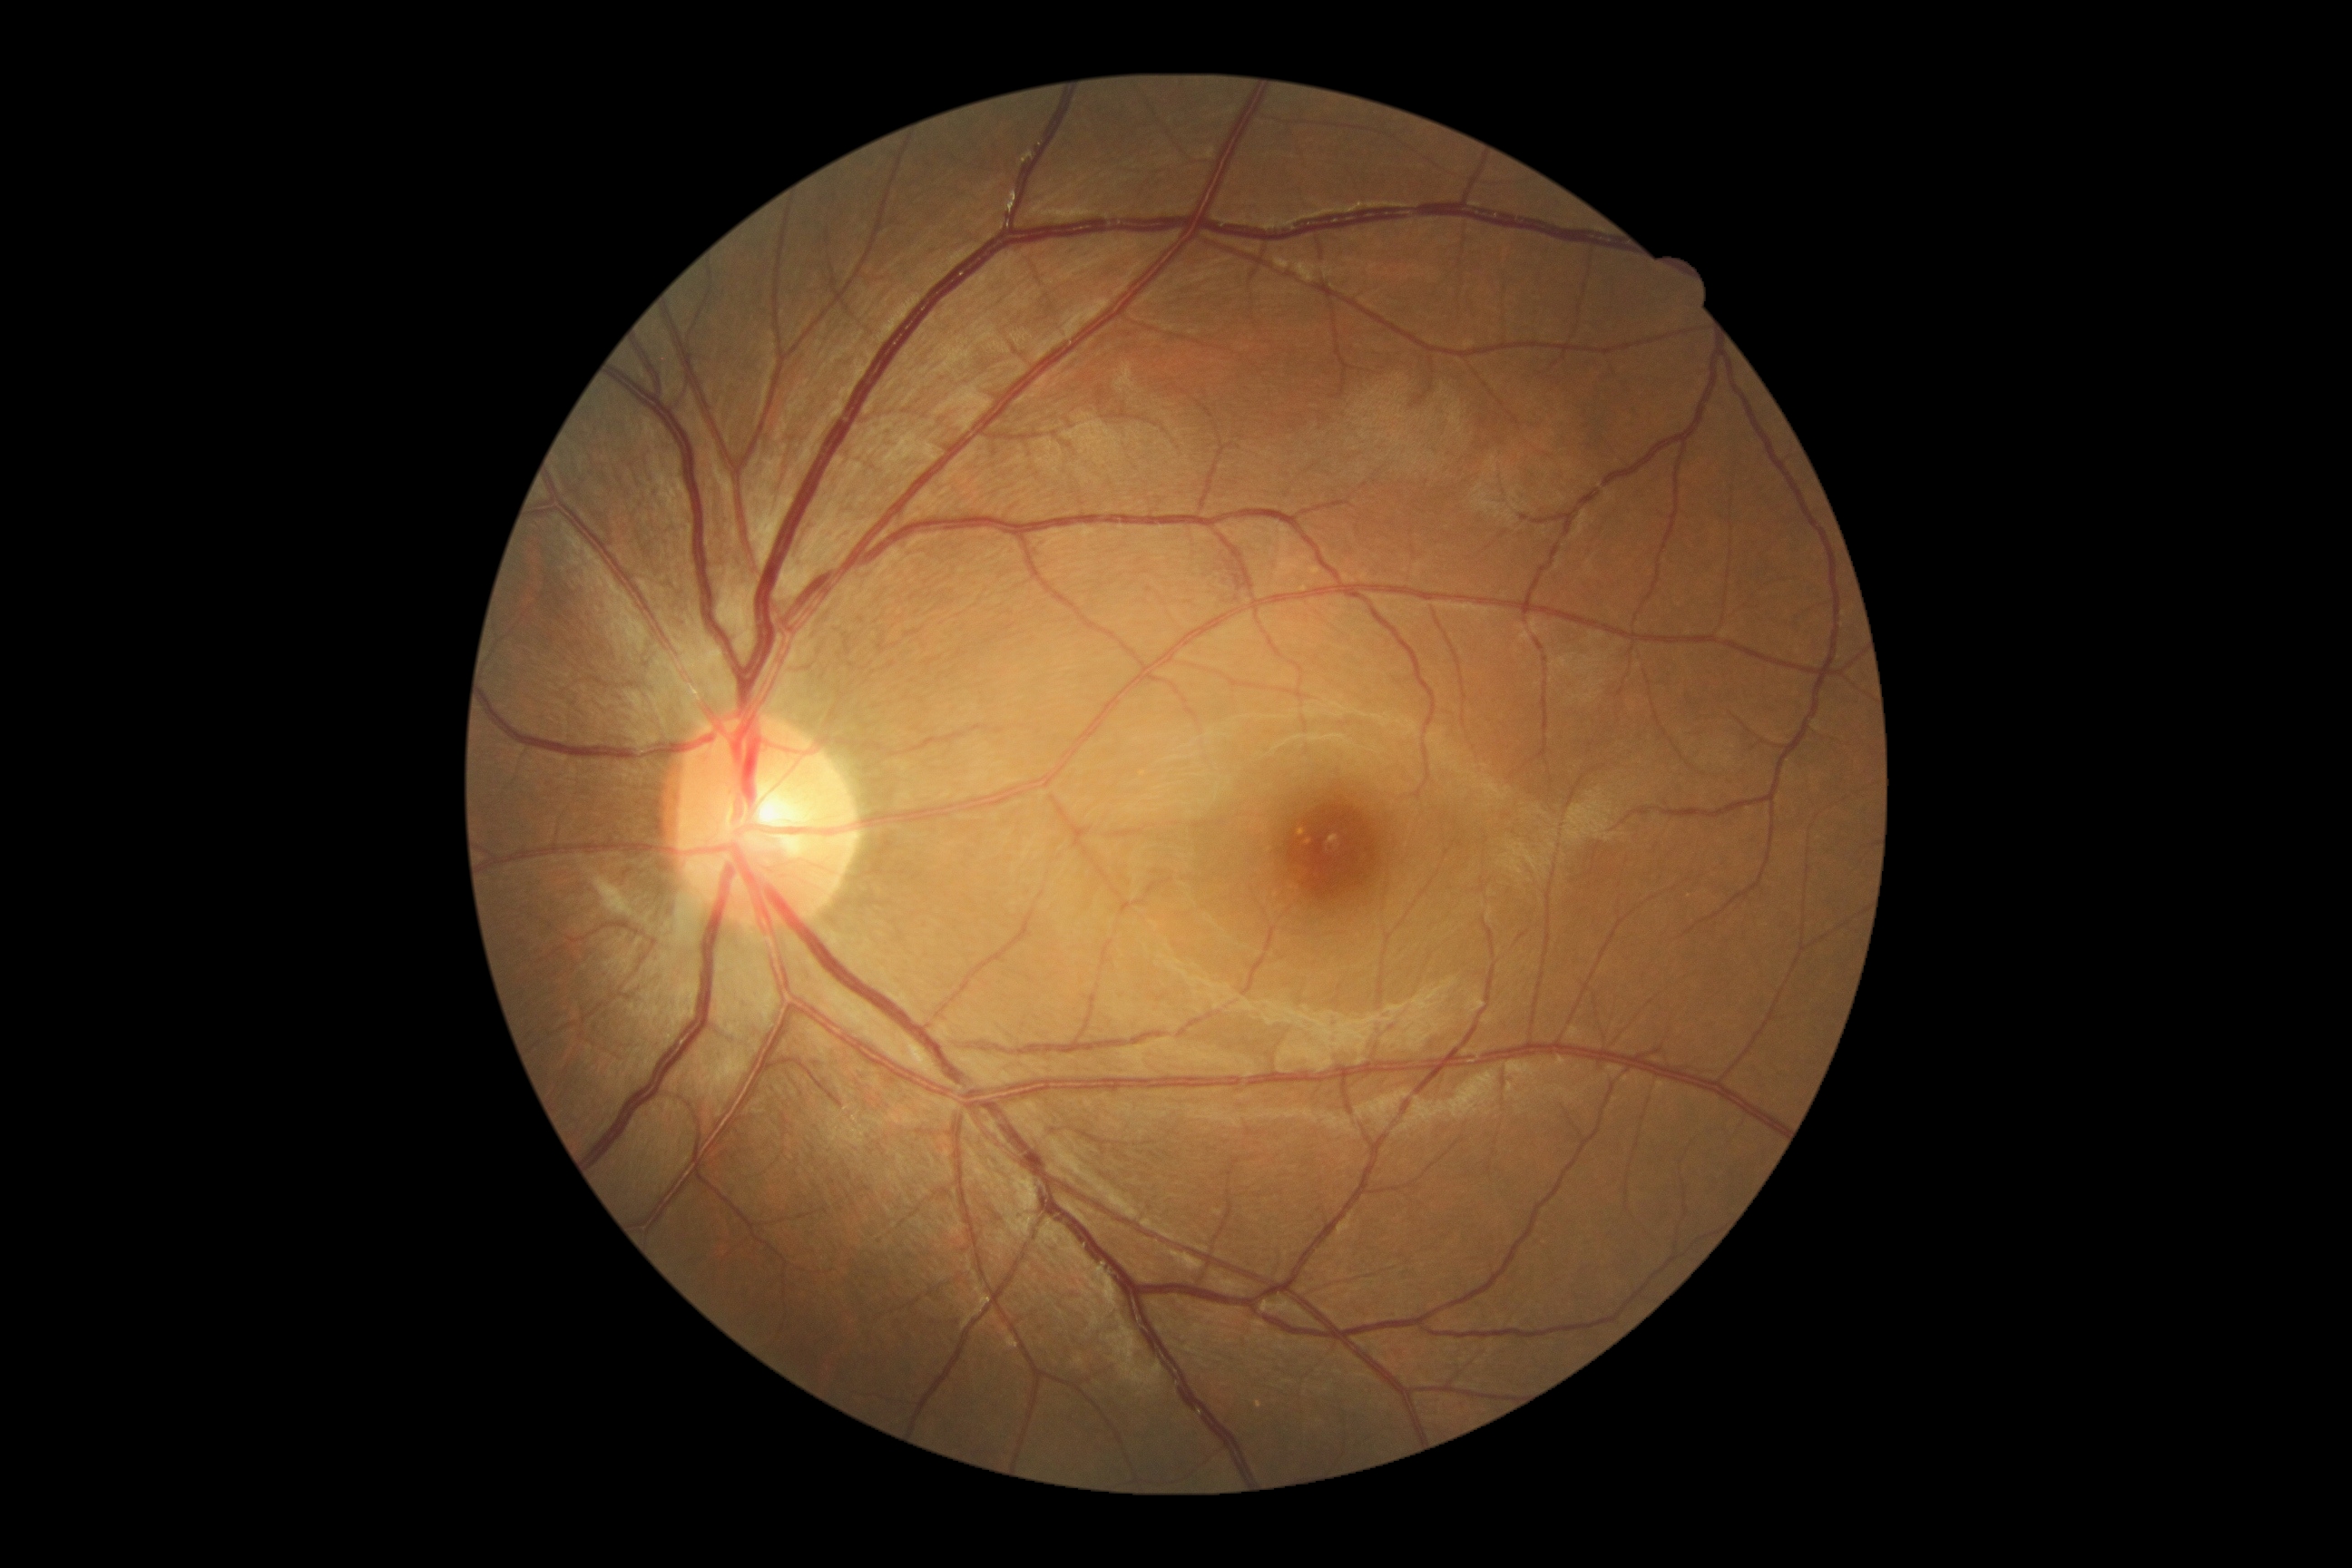 DR: no apparent retinopathy (grade 0).